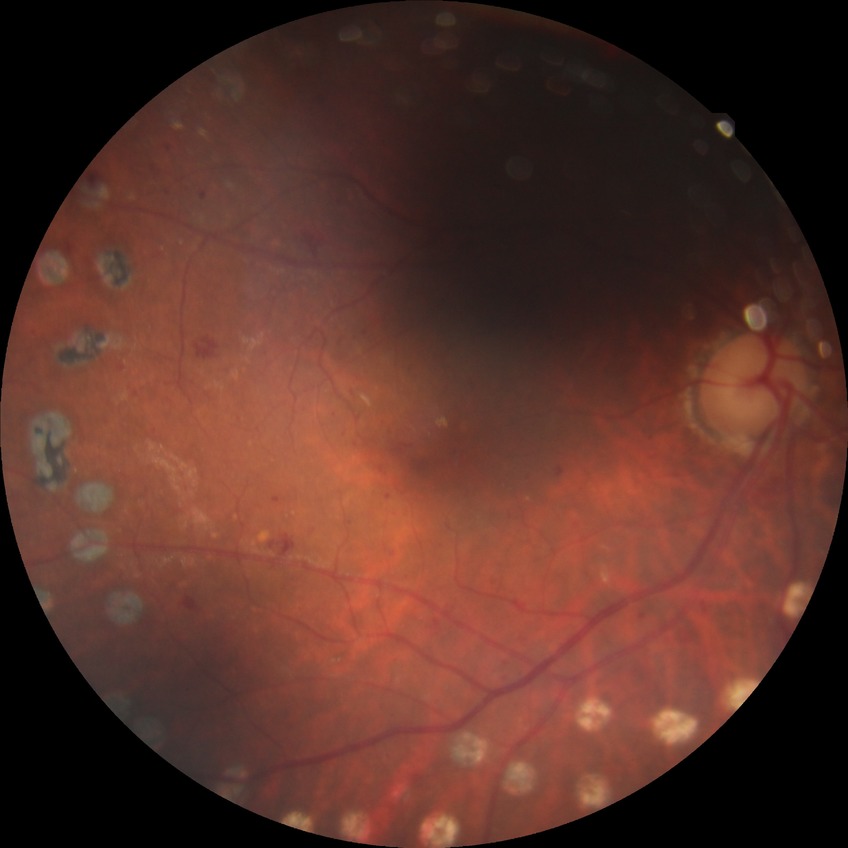 Diabetic retinopathy stage: proliferative diabetic retinopathy.